Graded on the modified Davis scale
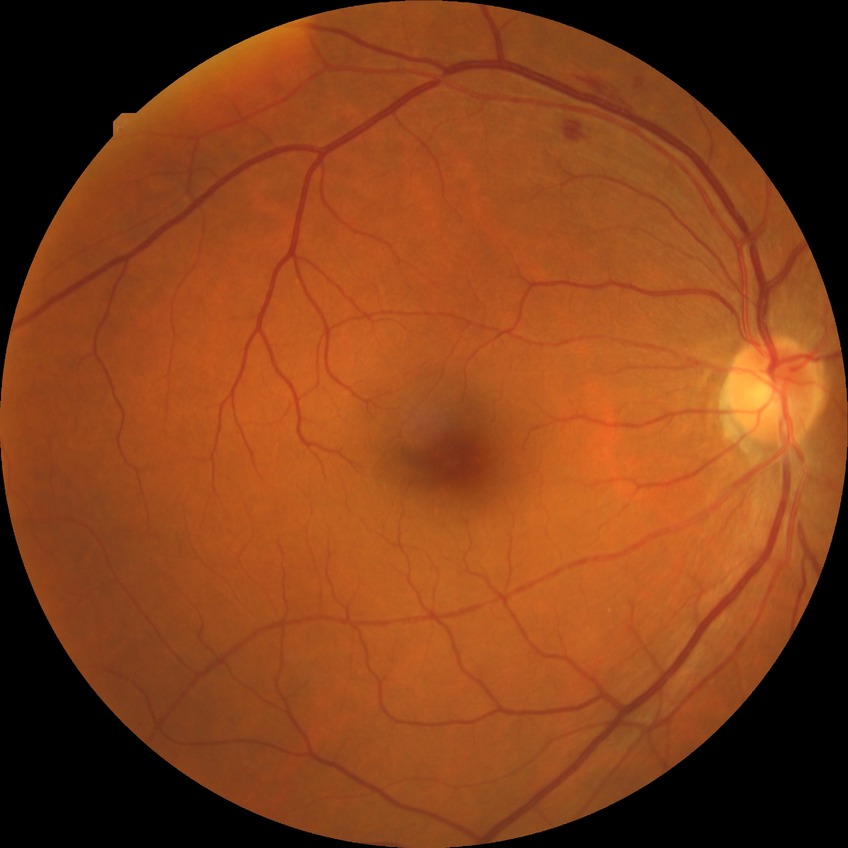
The retinopathy is classified as non-proliferative diabetic retinopathy. Diabetic retinopathy (DR): simple diabetic retinopathy (SDR).